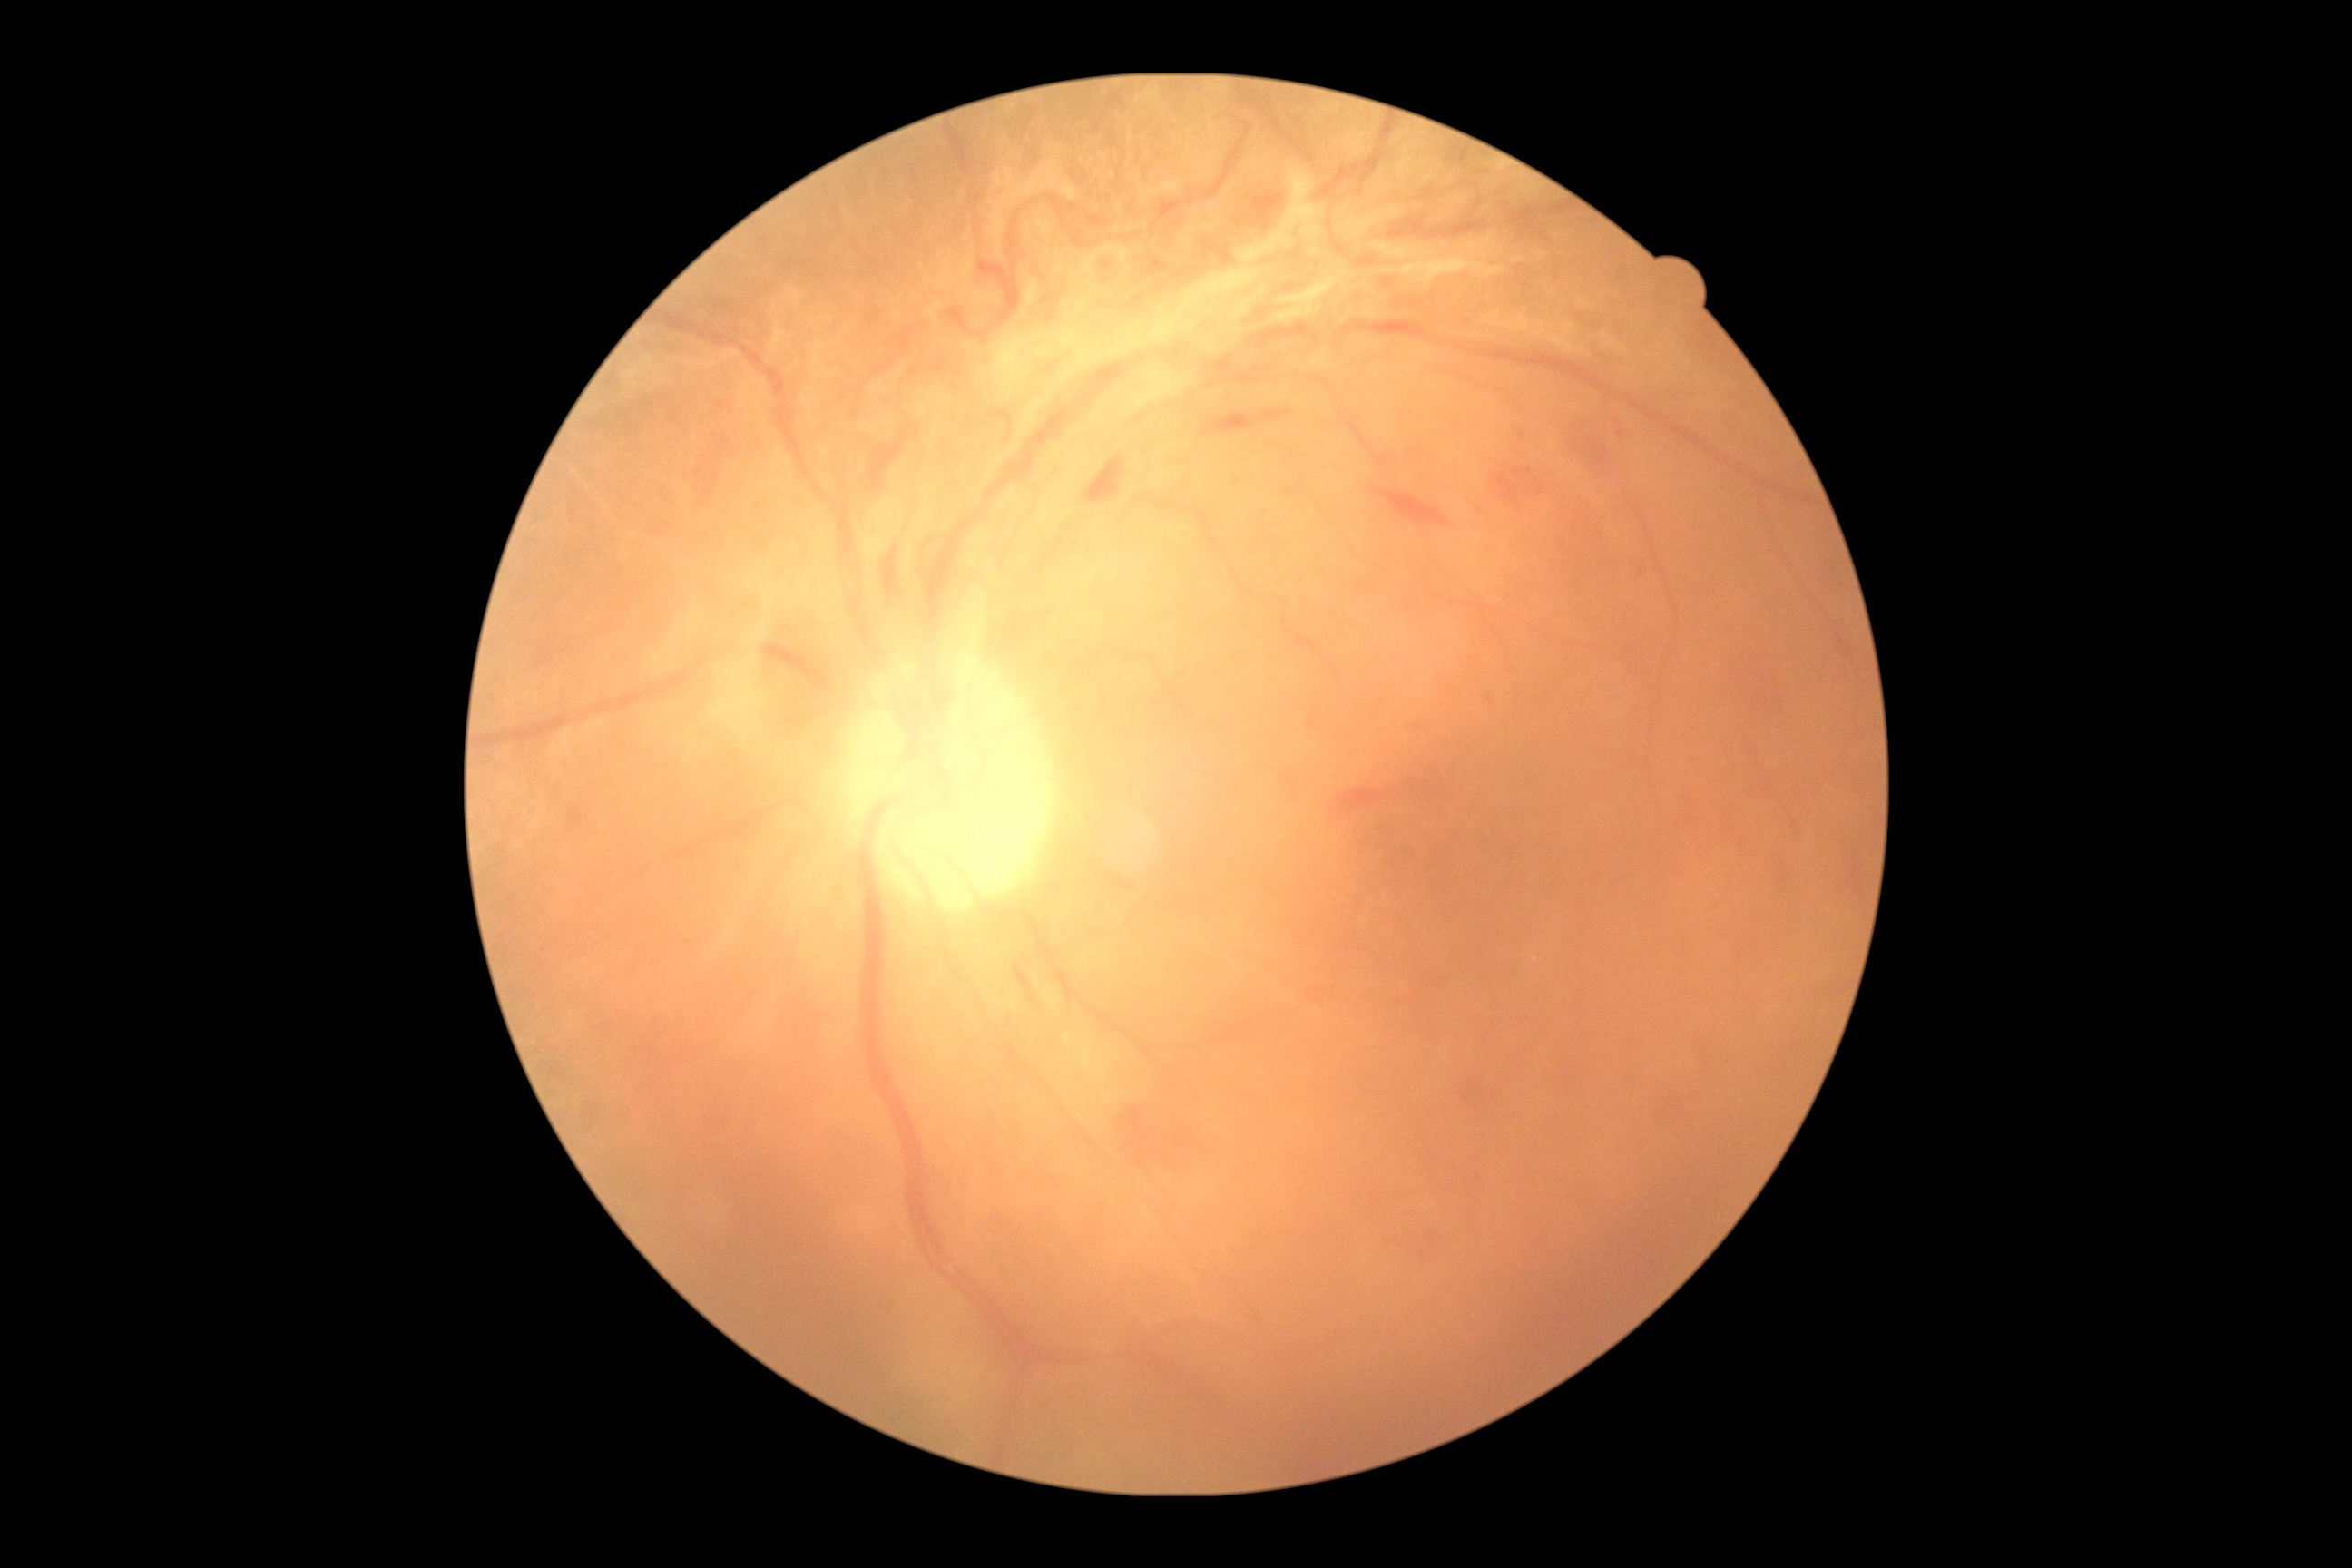

  dr_grade: 4 — neovascularization and/or vitreous/pre-retinal hemorrhage